CFP · nonmydriatic · NIDEK AFC-230 fundus camera · 848 by 848 pixels · FOV: 45 degrees — 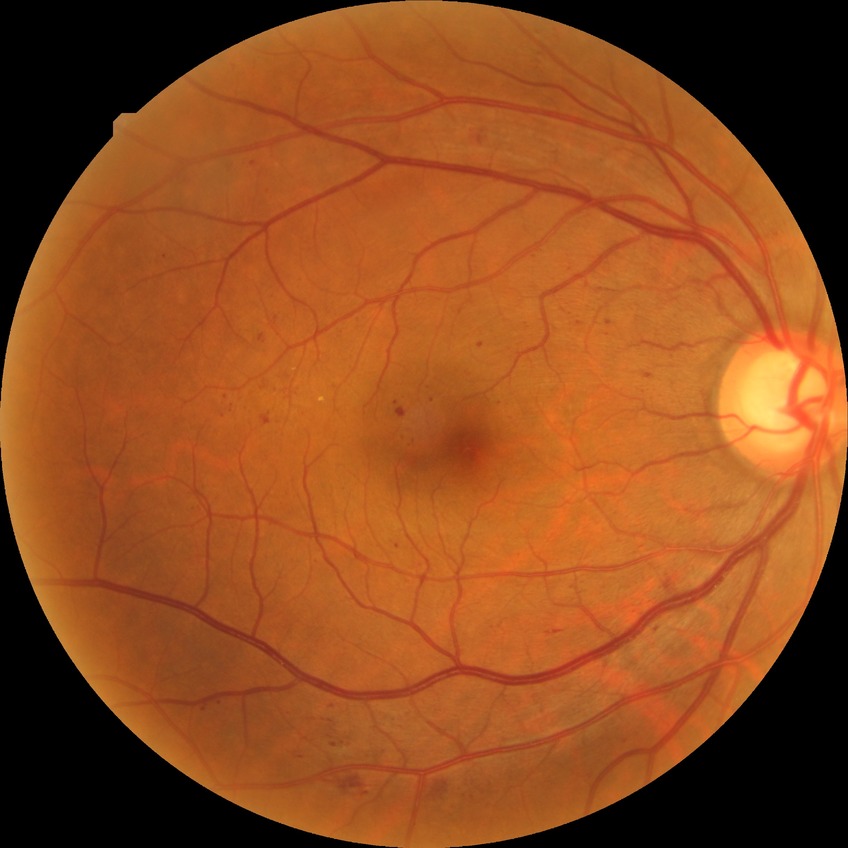
Diabetic retinopathy (DR): SDR (simple diabetic retinopathy).
Disease class: non-proliferative diabetic retinopathy.